50° field of view, CFP: 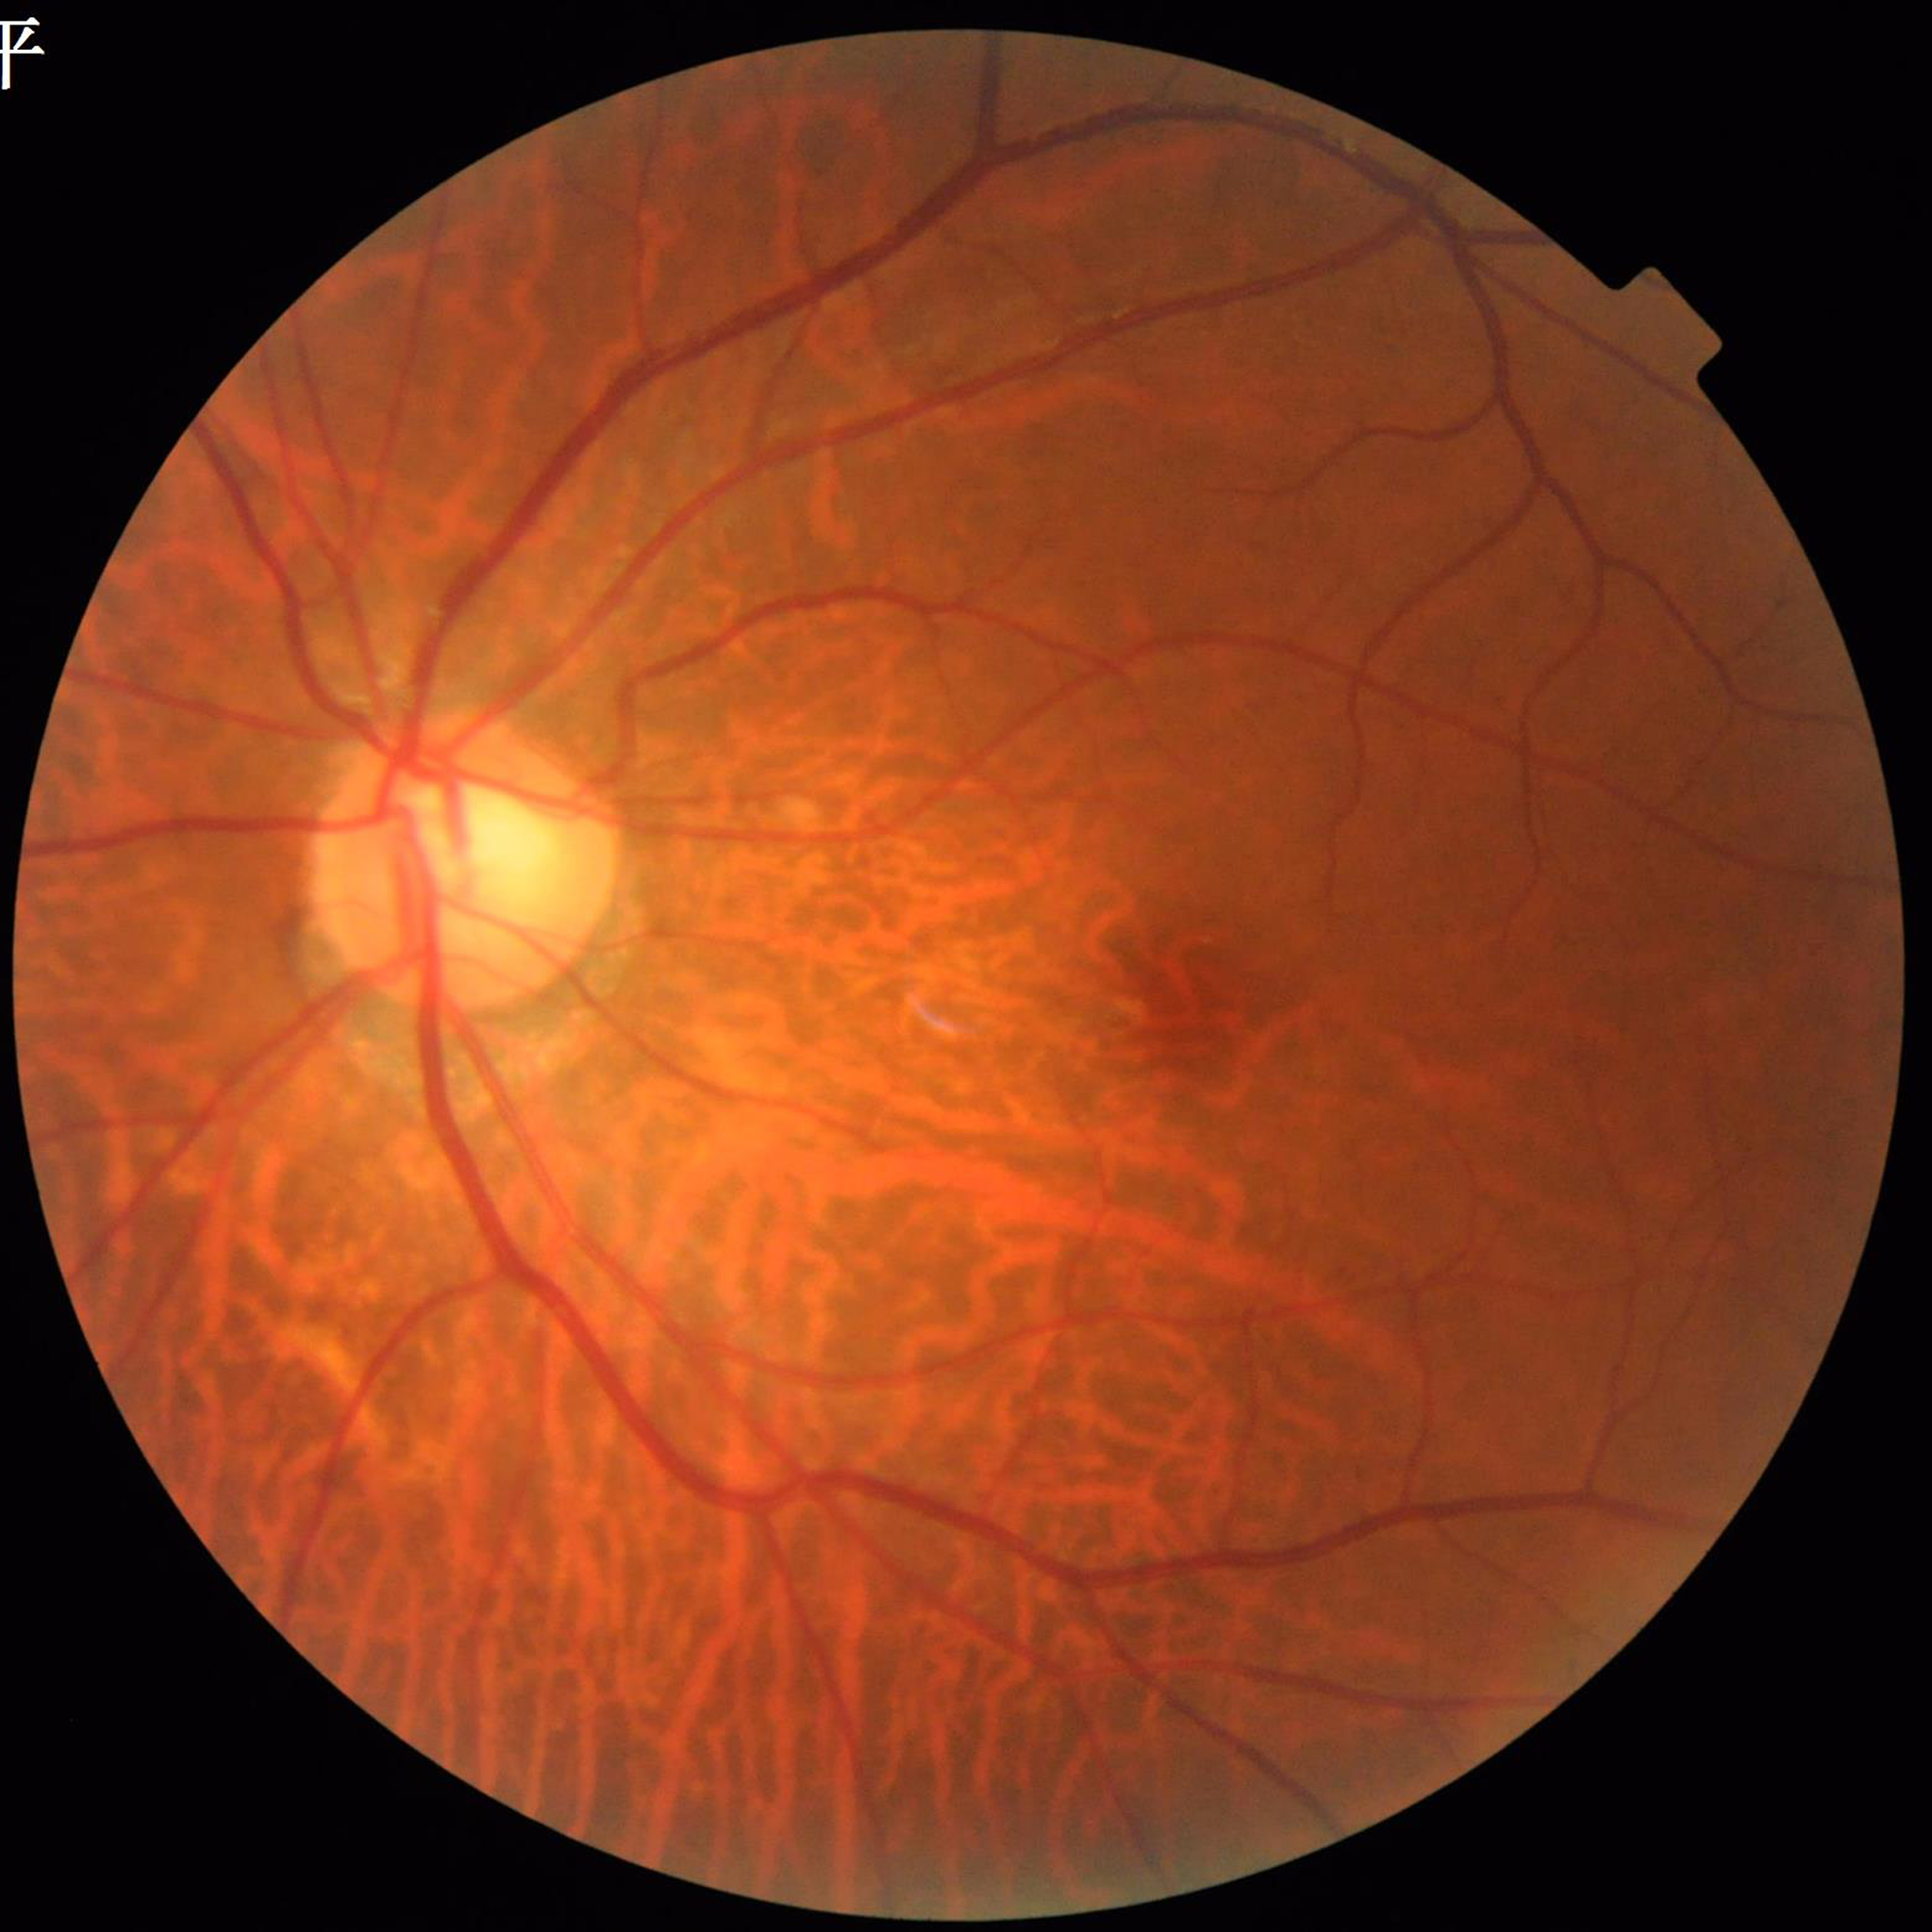
The patient was diagnosed with DR. Automated quality assessment: good.